Infant wide-field retinal image. Phoenix ICON, 100° FOV: 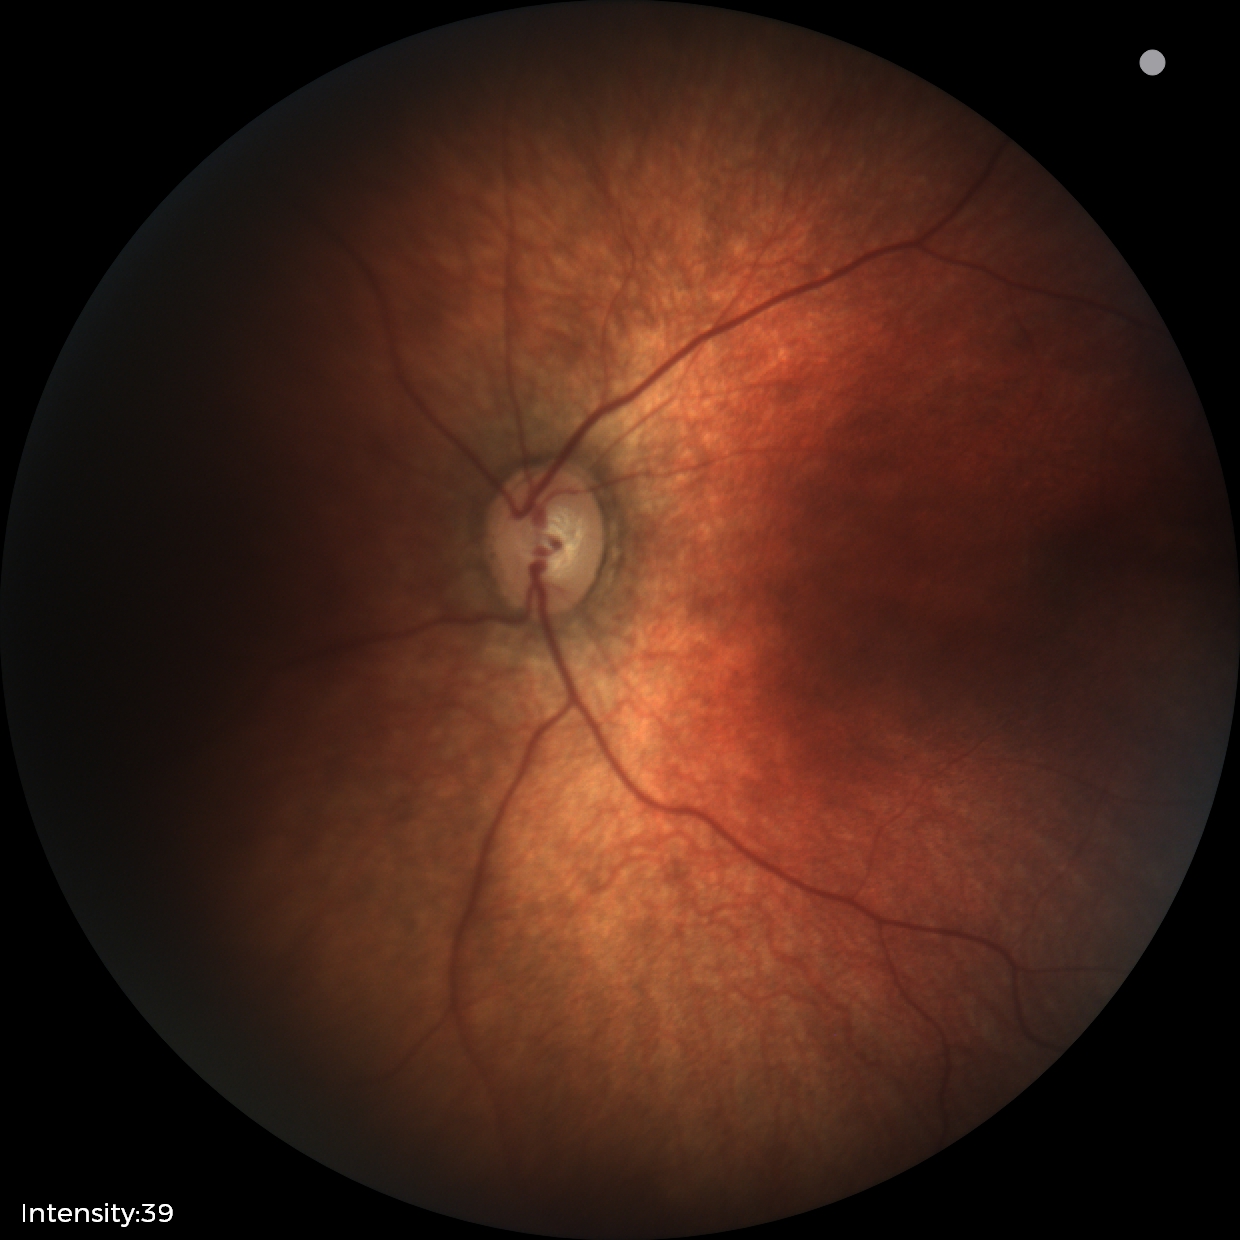

Screening diagnosis: normal fundus examination.